Wide-field fundus photograph from neonatal ROP screening — 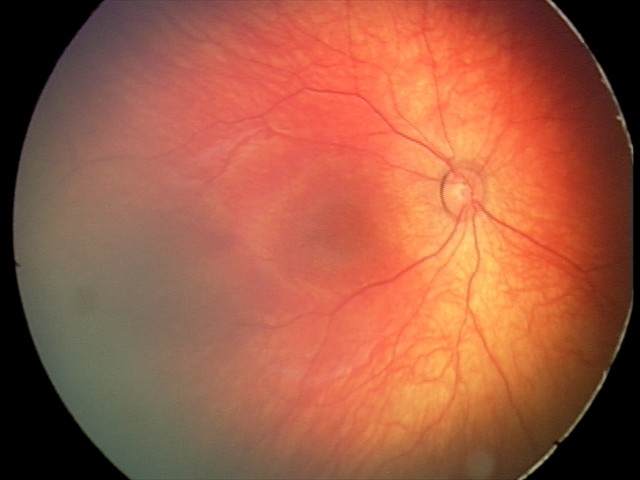 Diagnosis from this screening exam: retinal hemorrhages.